Captured with the Phoenix ICON (100° field of view); pediatric wide-field fundus photograph
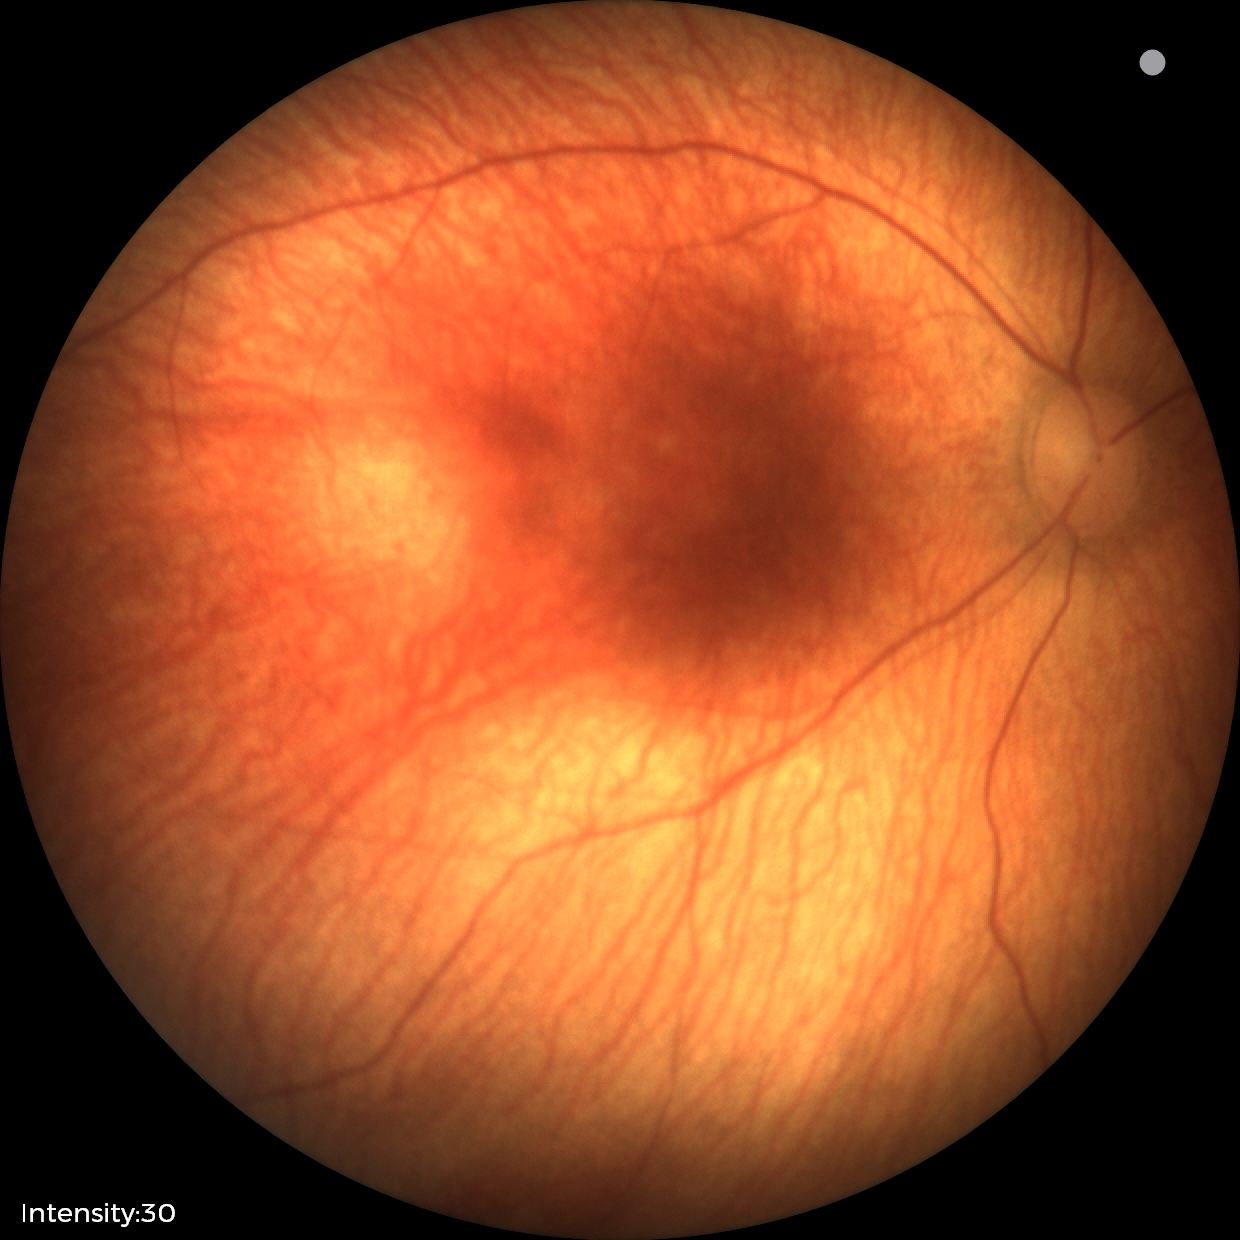 Examination with physiological retinal findings.